Image size 2352x1568: 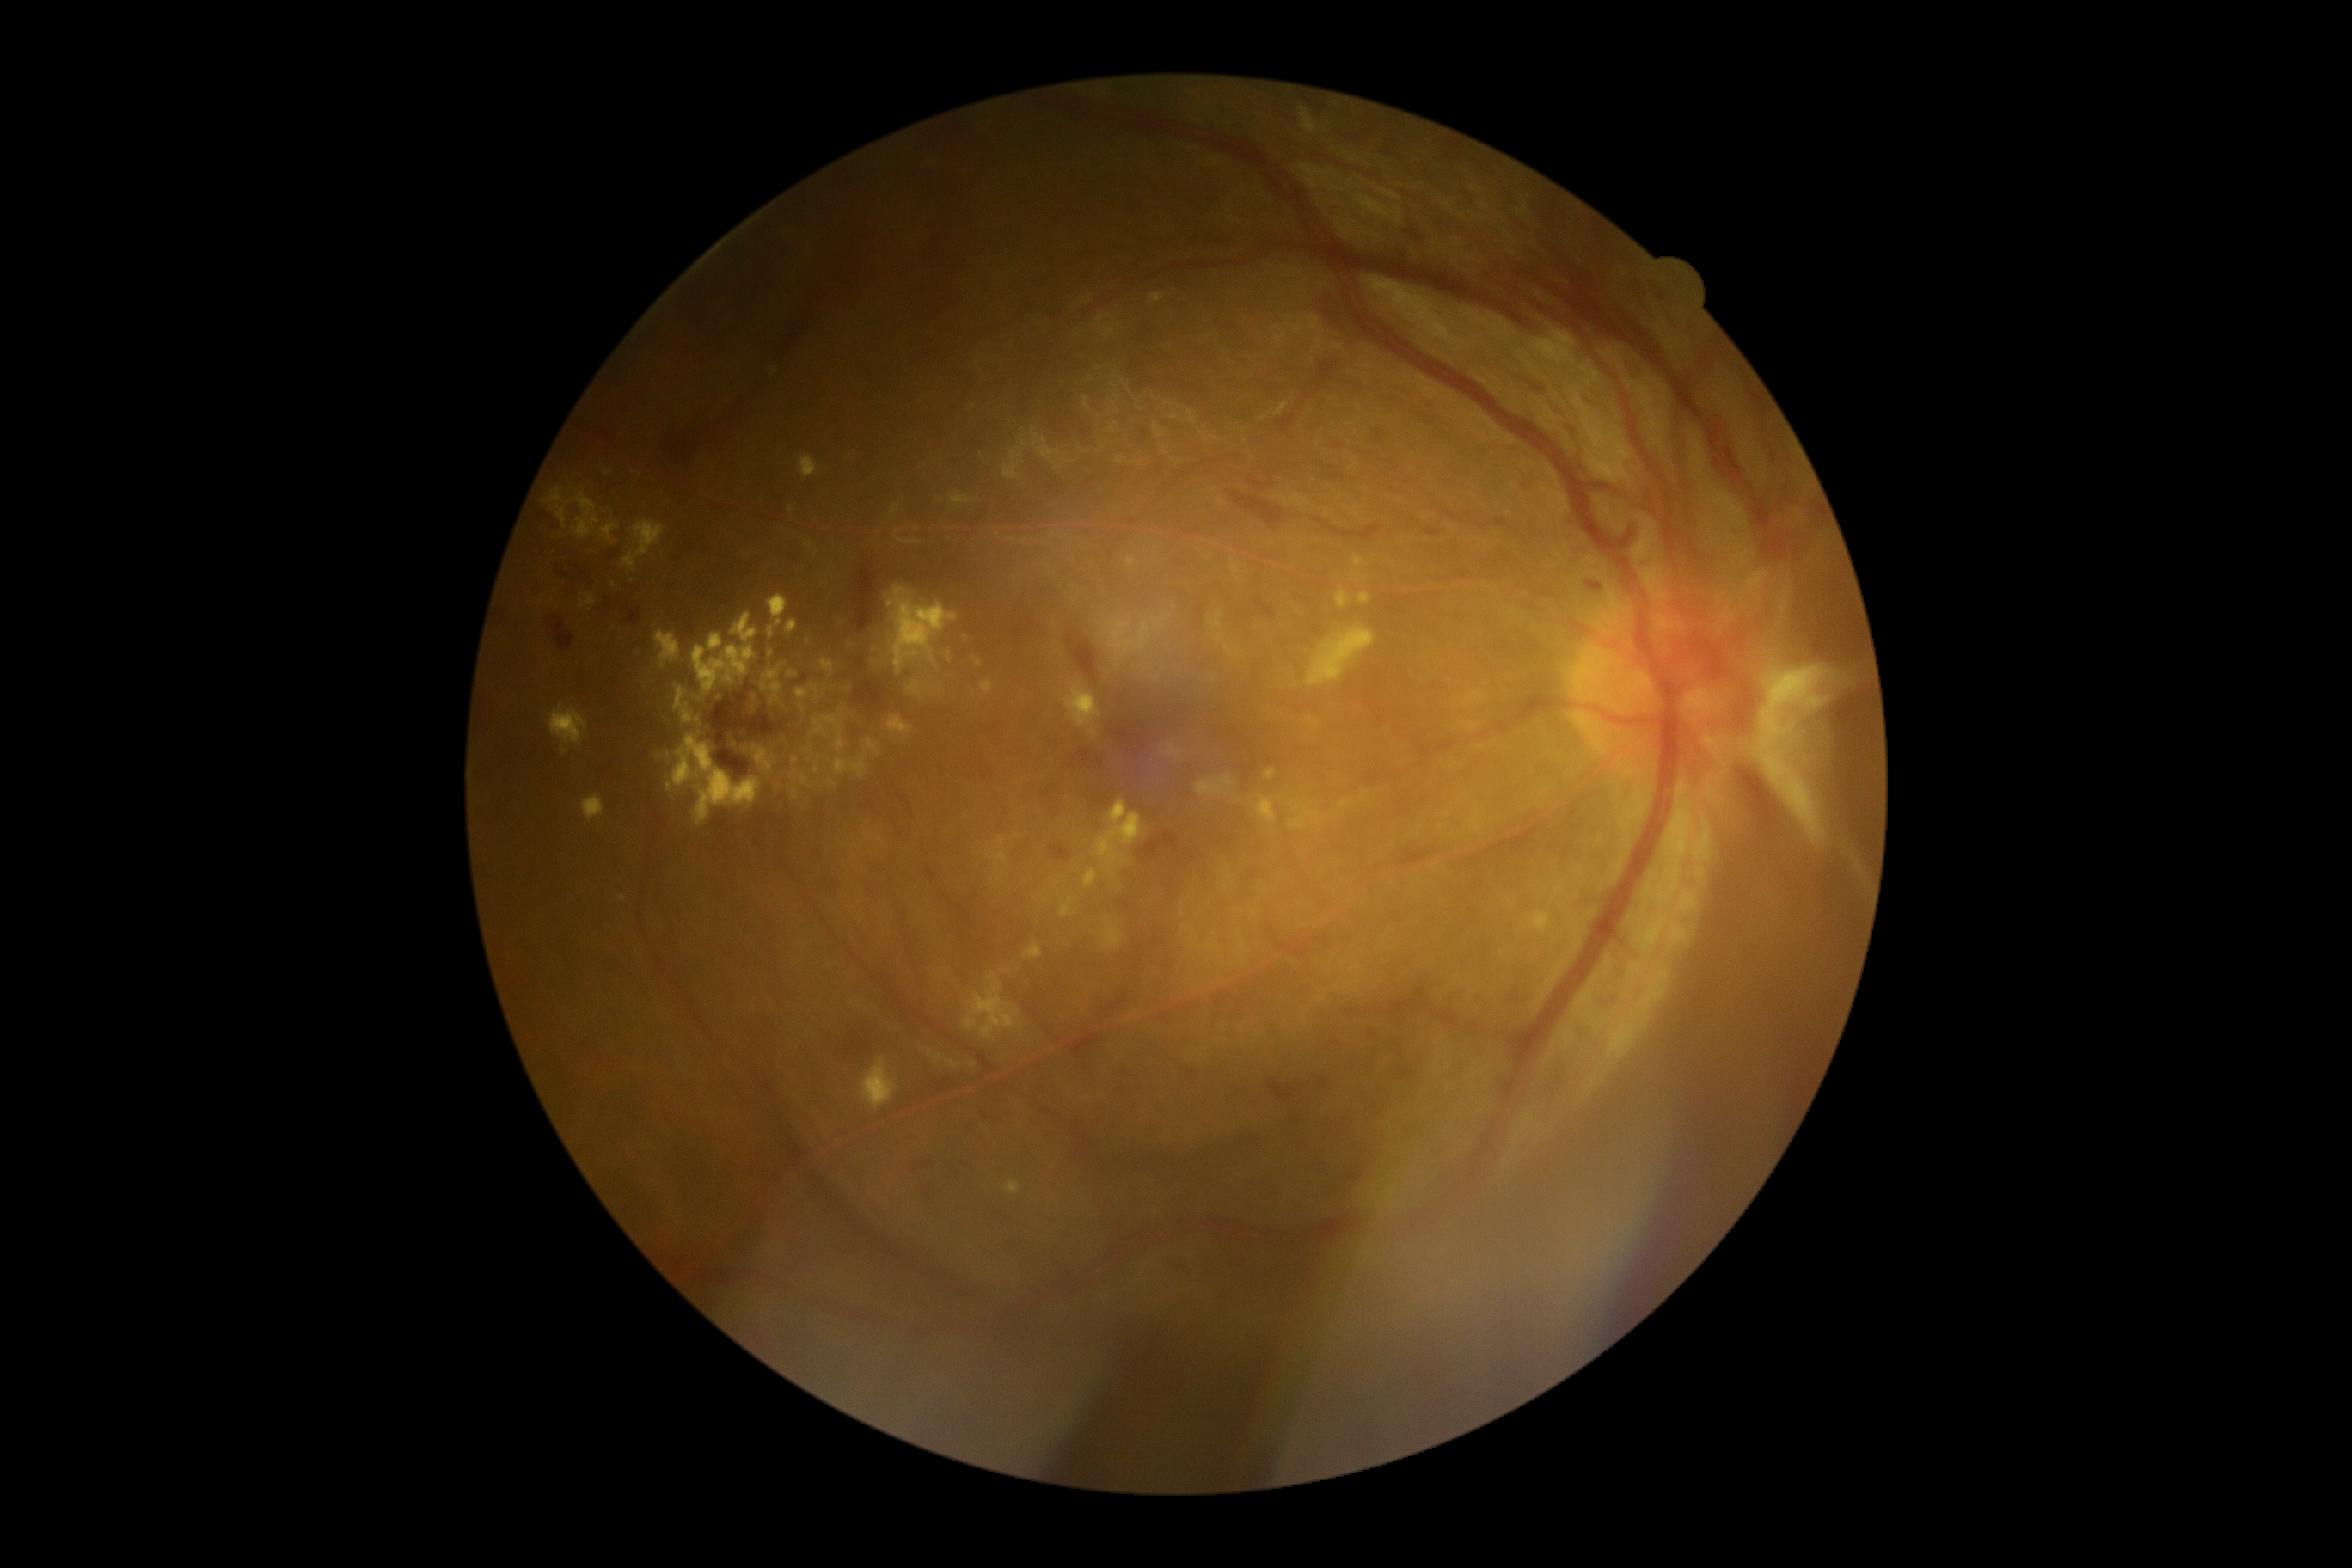 Retinopathy: grade 4 (PDR) — neovascularization and/or vitreous/pre-retinal hemorrhage
Lesions identified (partial list):
hard exudates (partial) = 835,756,867,776; 561,747,567,756; 763,675,768,692; 948,654,952,663; 1005,1182,1020,1196; 579,592,597,609; 1359,594,1371,604; 799,455,819,479; 549,487,572,530; 805,542,812,551; 819,658,835,677; 694,646,754,695; 582,795,604,823; 1337,591,1351,608; 773,683,783,697
Small hard exudates approximately at (x=931, y=164); (x=796, y=760)